848 by 848 pixels. No pharmacologic dilation. NIDEK AFC-230.
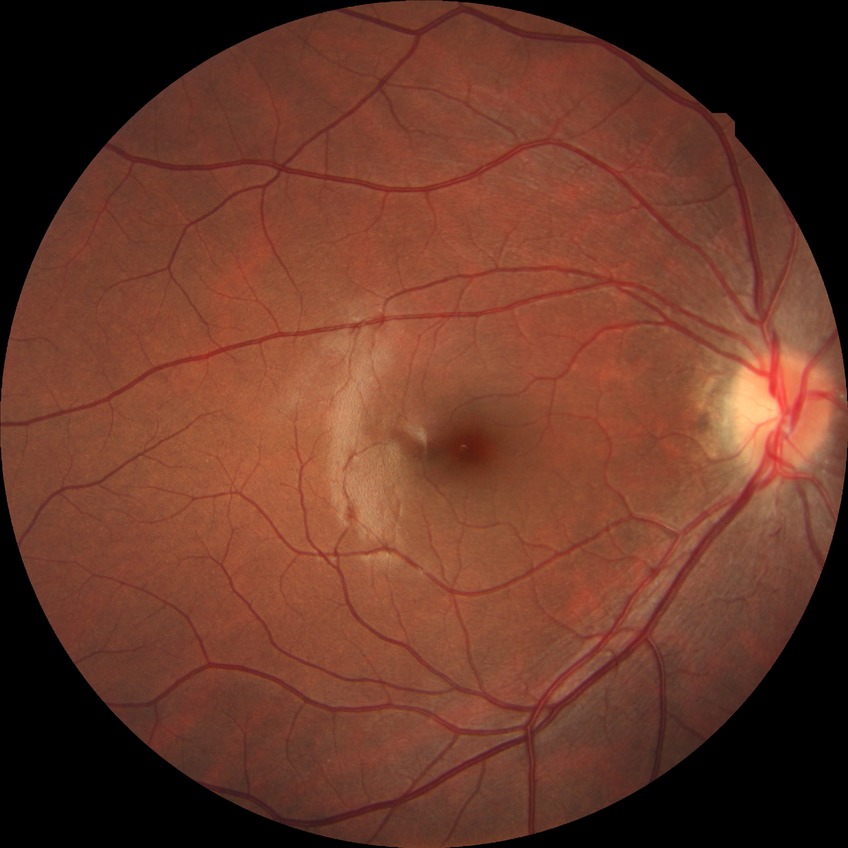
Diabetic retinopathy (DR) is no diabetic retinopathy (NDR).